Image size 1240x1240. Phoenix ICON, 100° FOV. Infant wide-field fundus photograph — 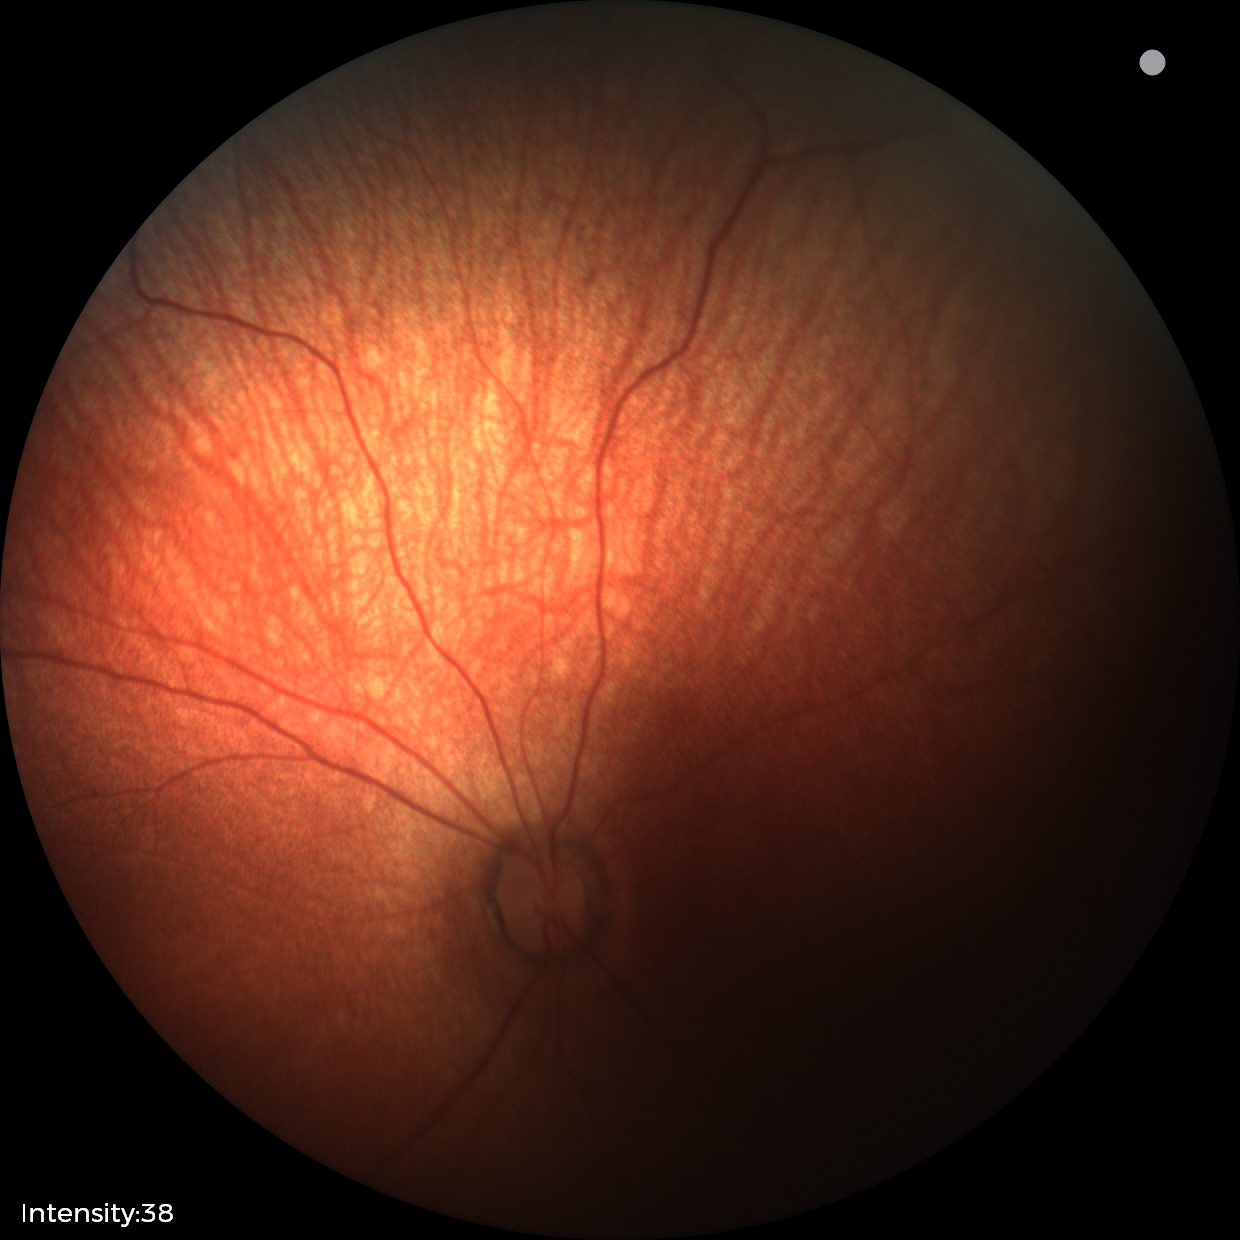 No retinal pathology identified on screening.